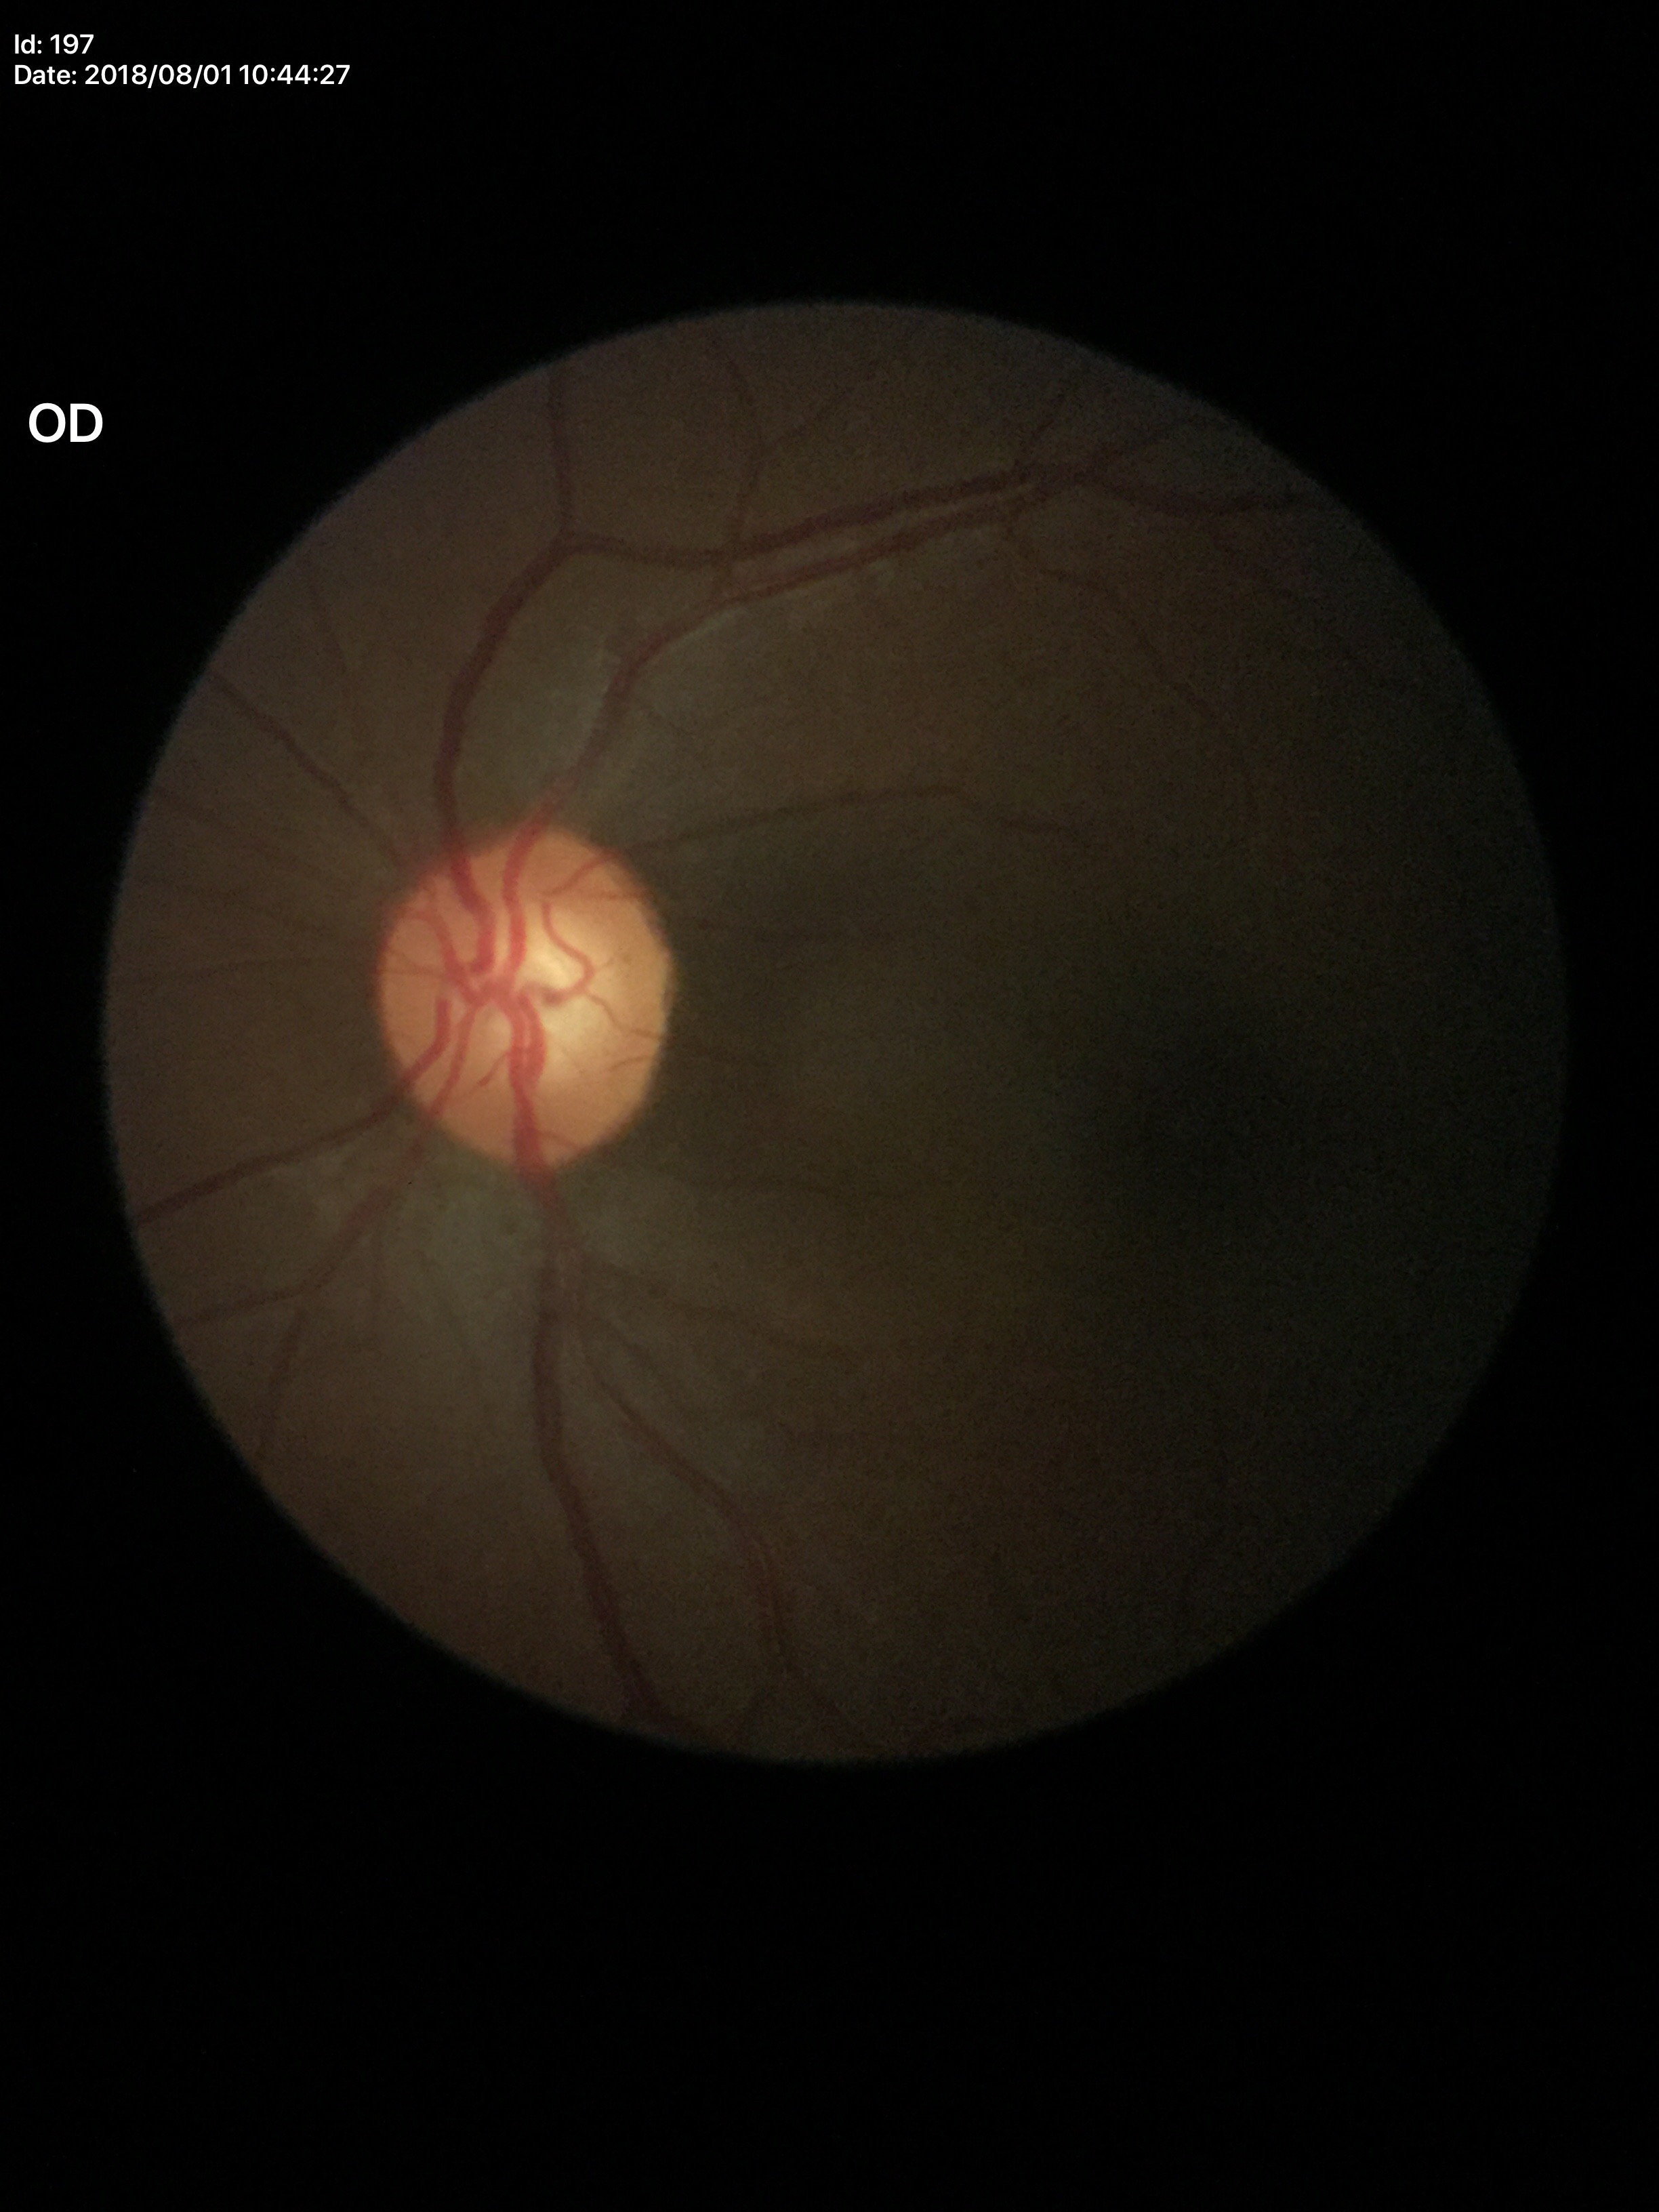 Glaucoma screening = no suspicious findings (2 of 5 graders flagged glaucoma suspect), ACDR = 0.35, VCDR = 0.59, HCDR = 0.60.